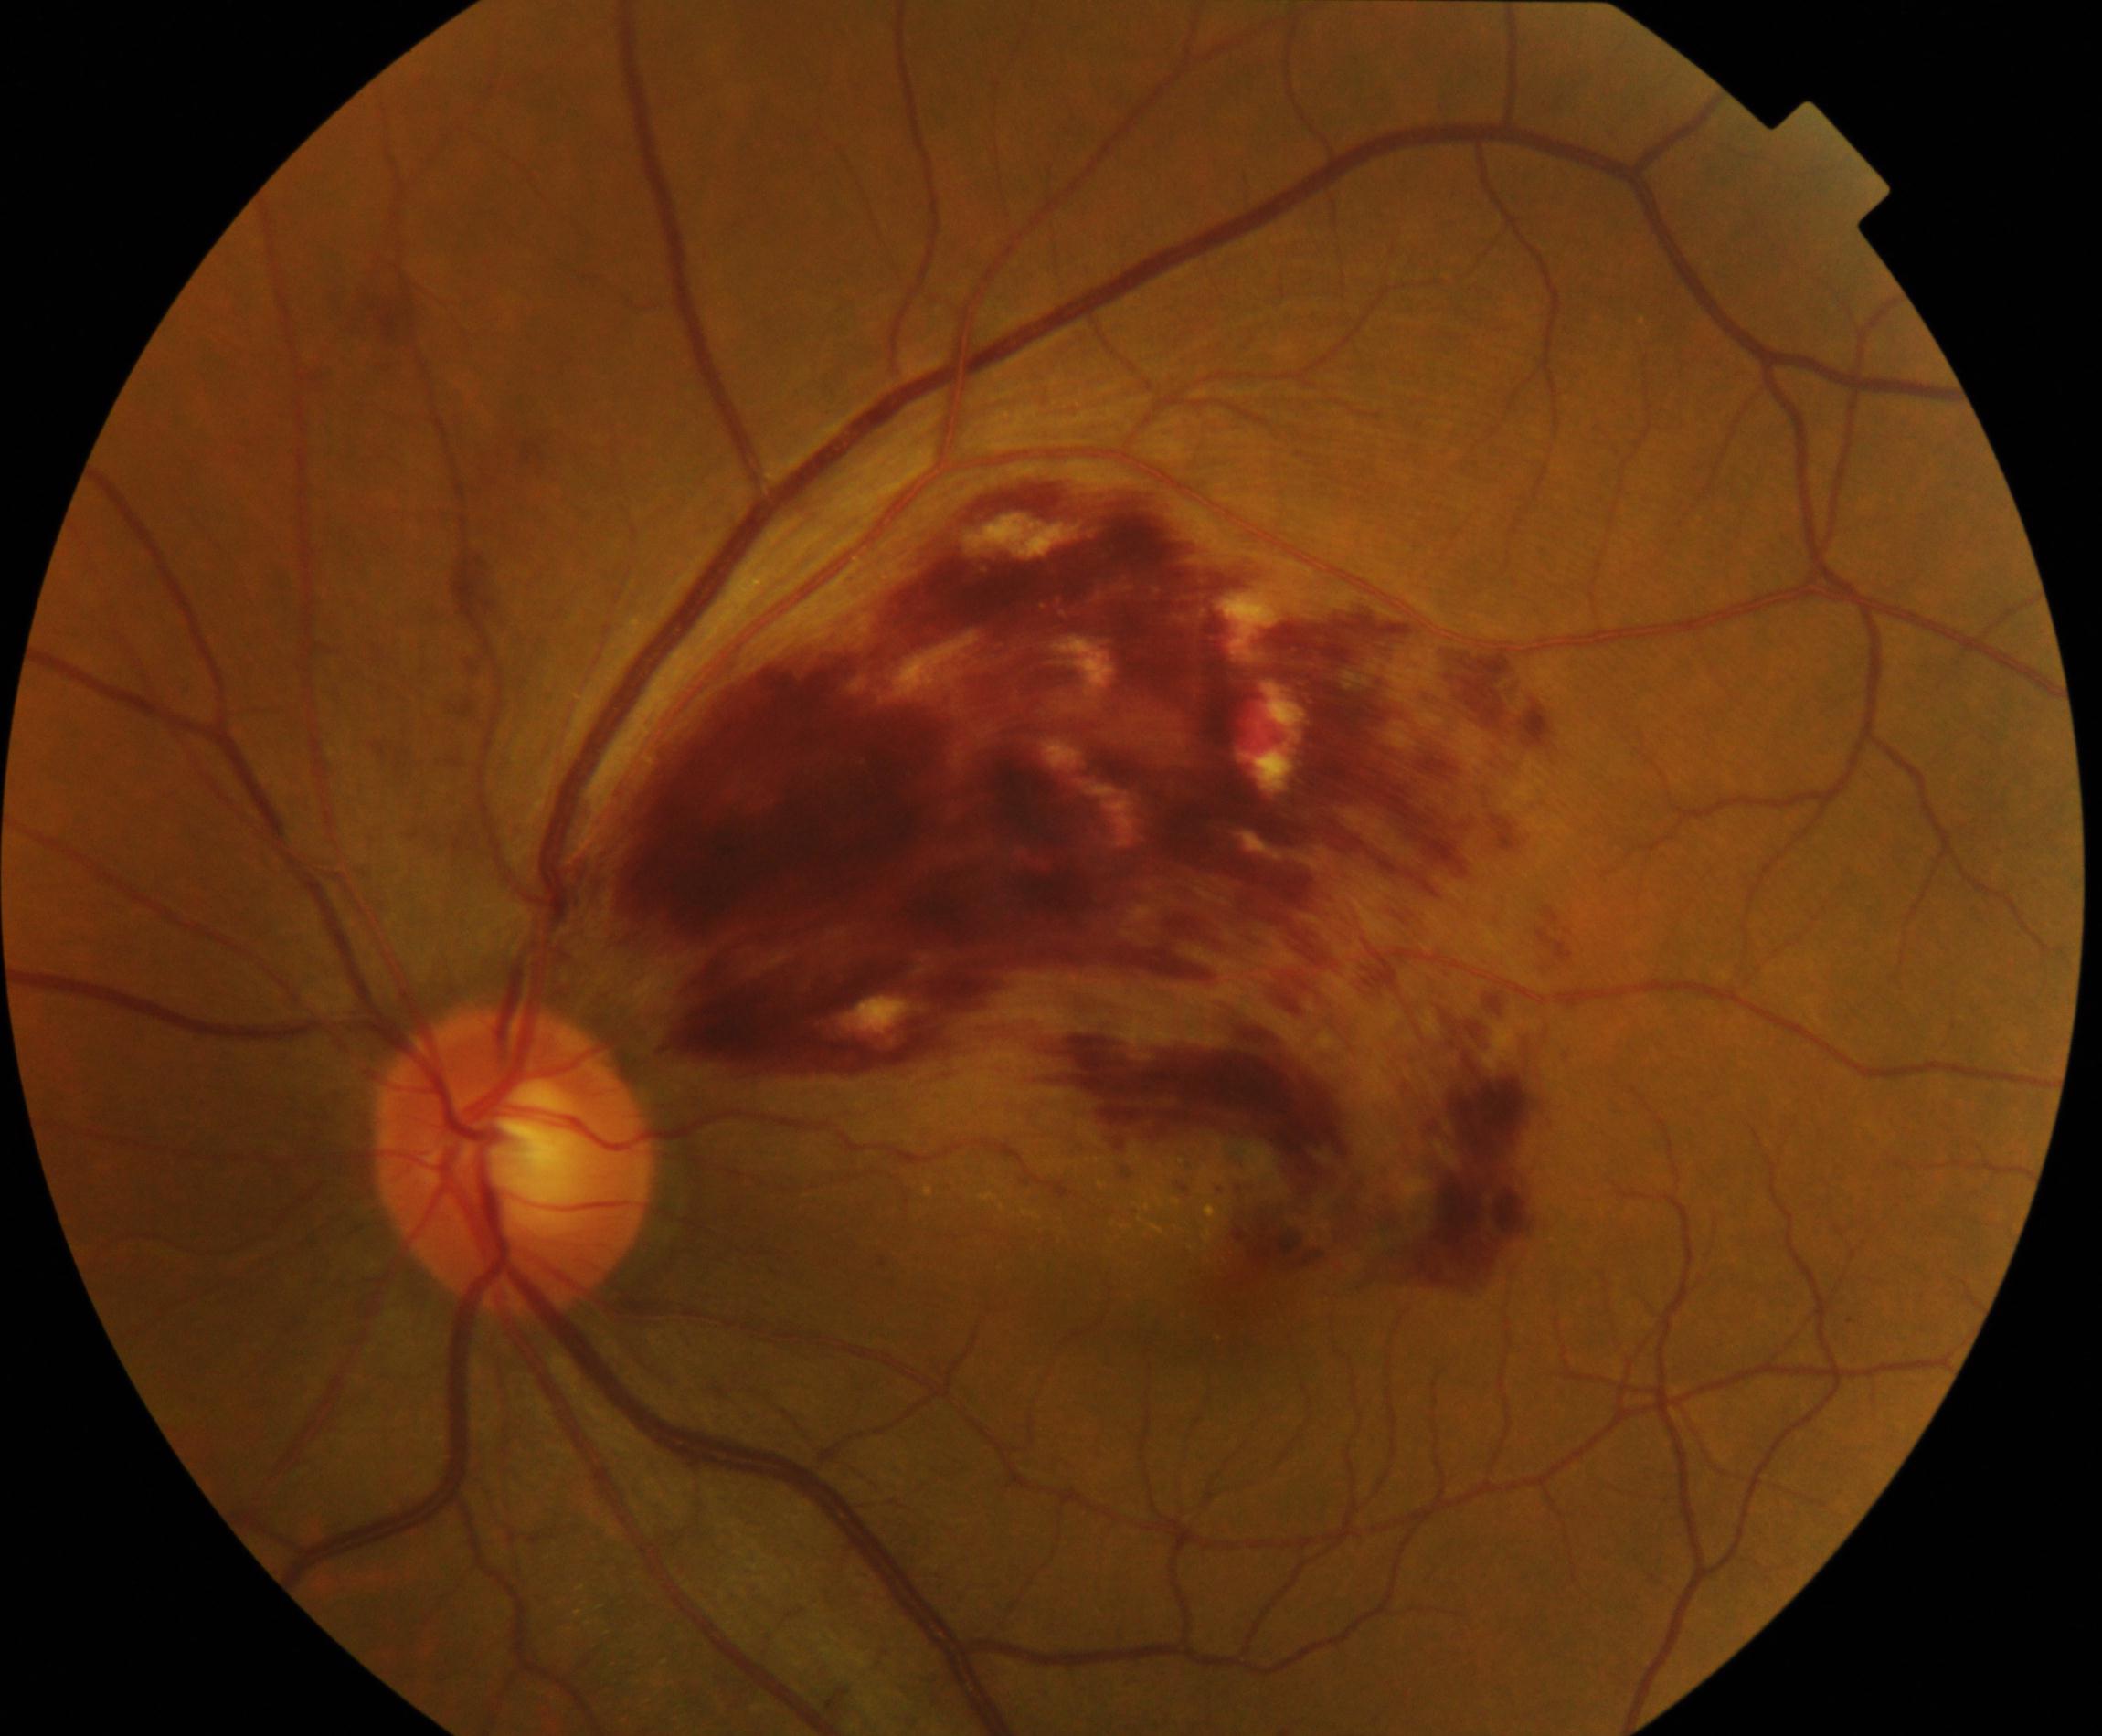

Color fundus photograph showing branch retinal vein occlusion.